45° FOV: 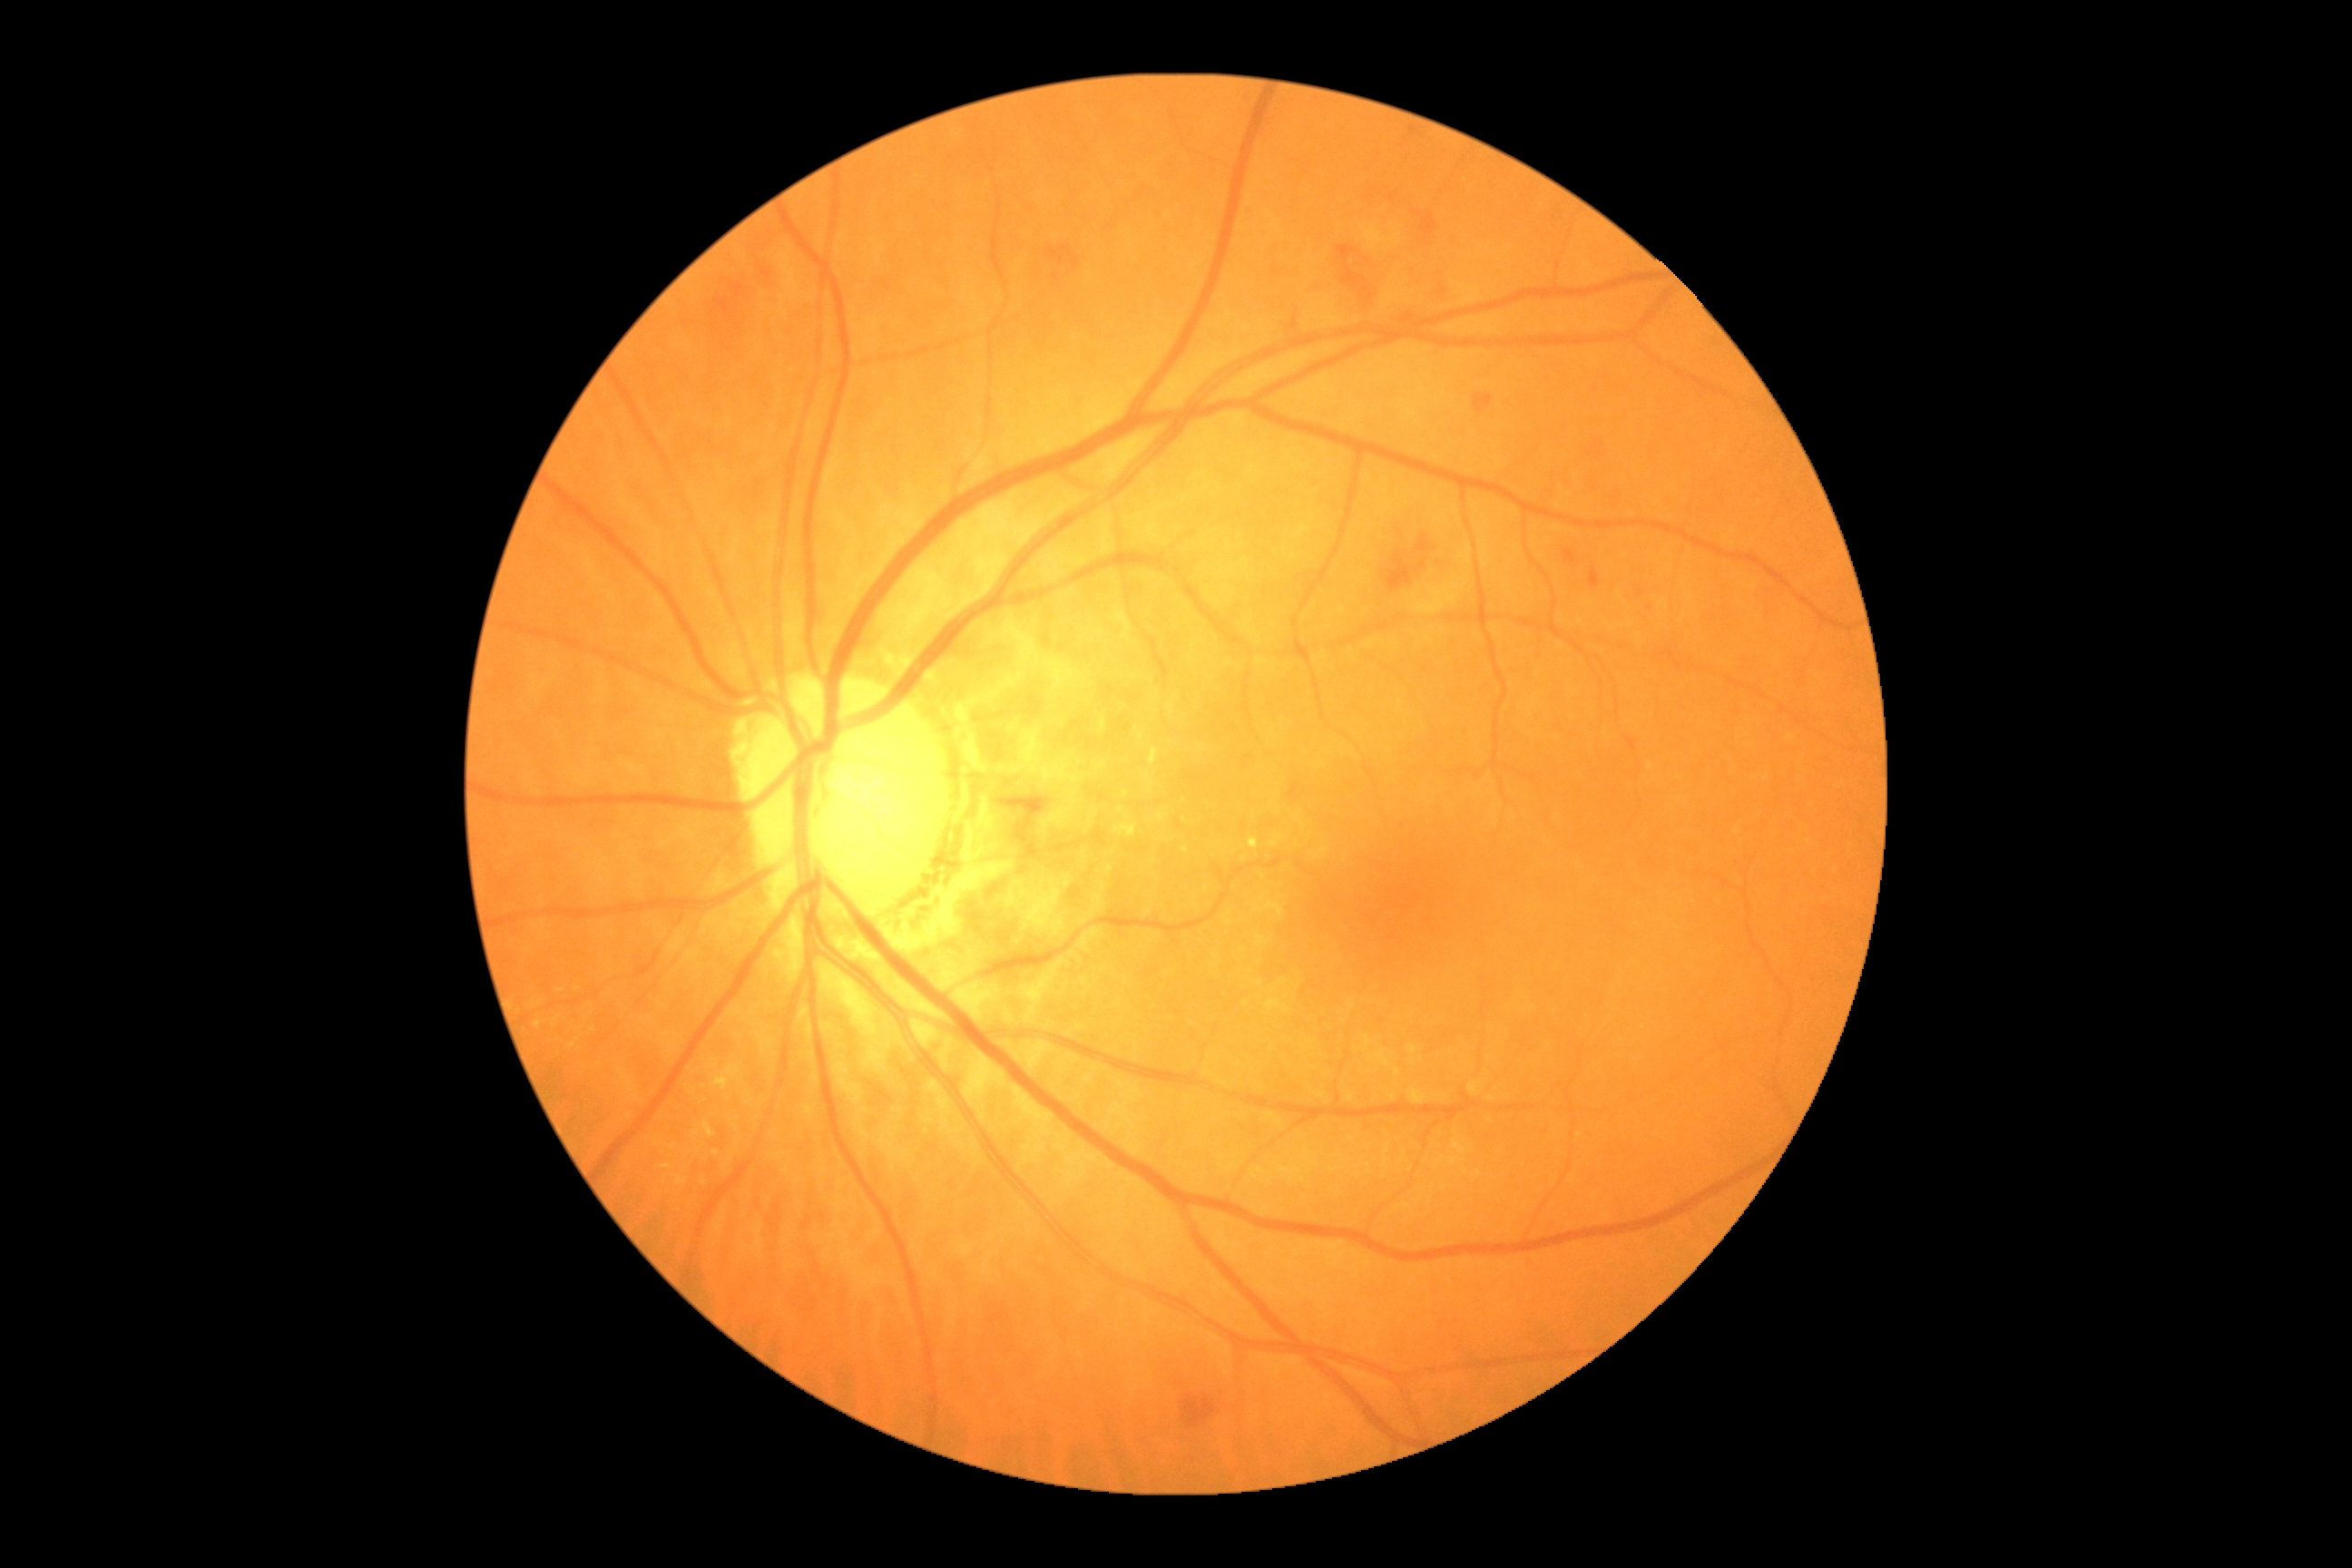 Findings:
* DR grade: 2/4